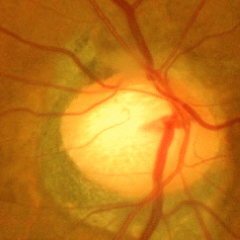
Glaucomatous optic neuropathy is present. Glaucoma stage: advanced glaucomatous optic neuropathy.